640 by 480 pixels; wide-field fundus photograph of an infant
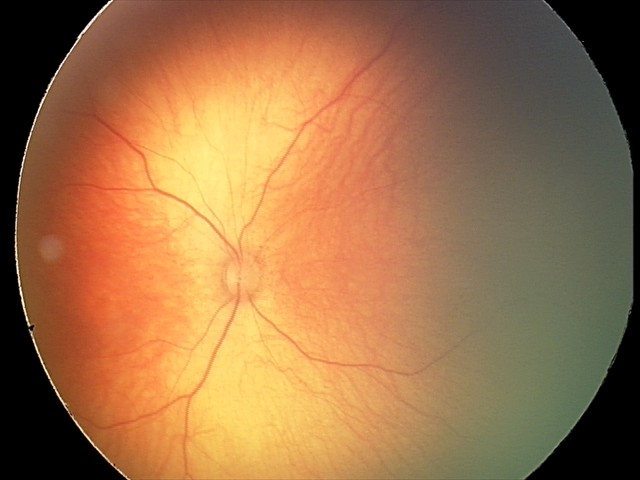

Screening examination diagnosed as physiological.